Camera: Remidio FOP fundus camera, fundus photo, image size 1659x2212:
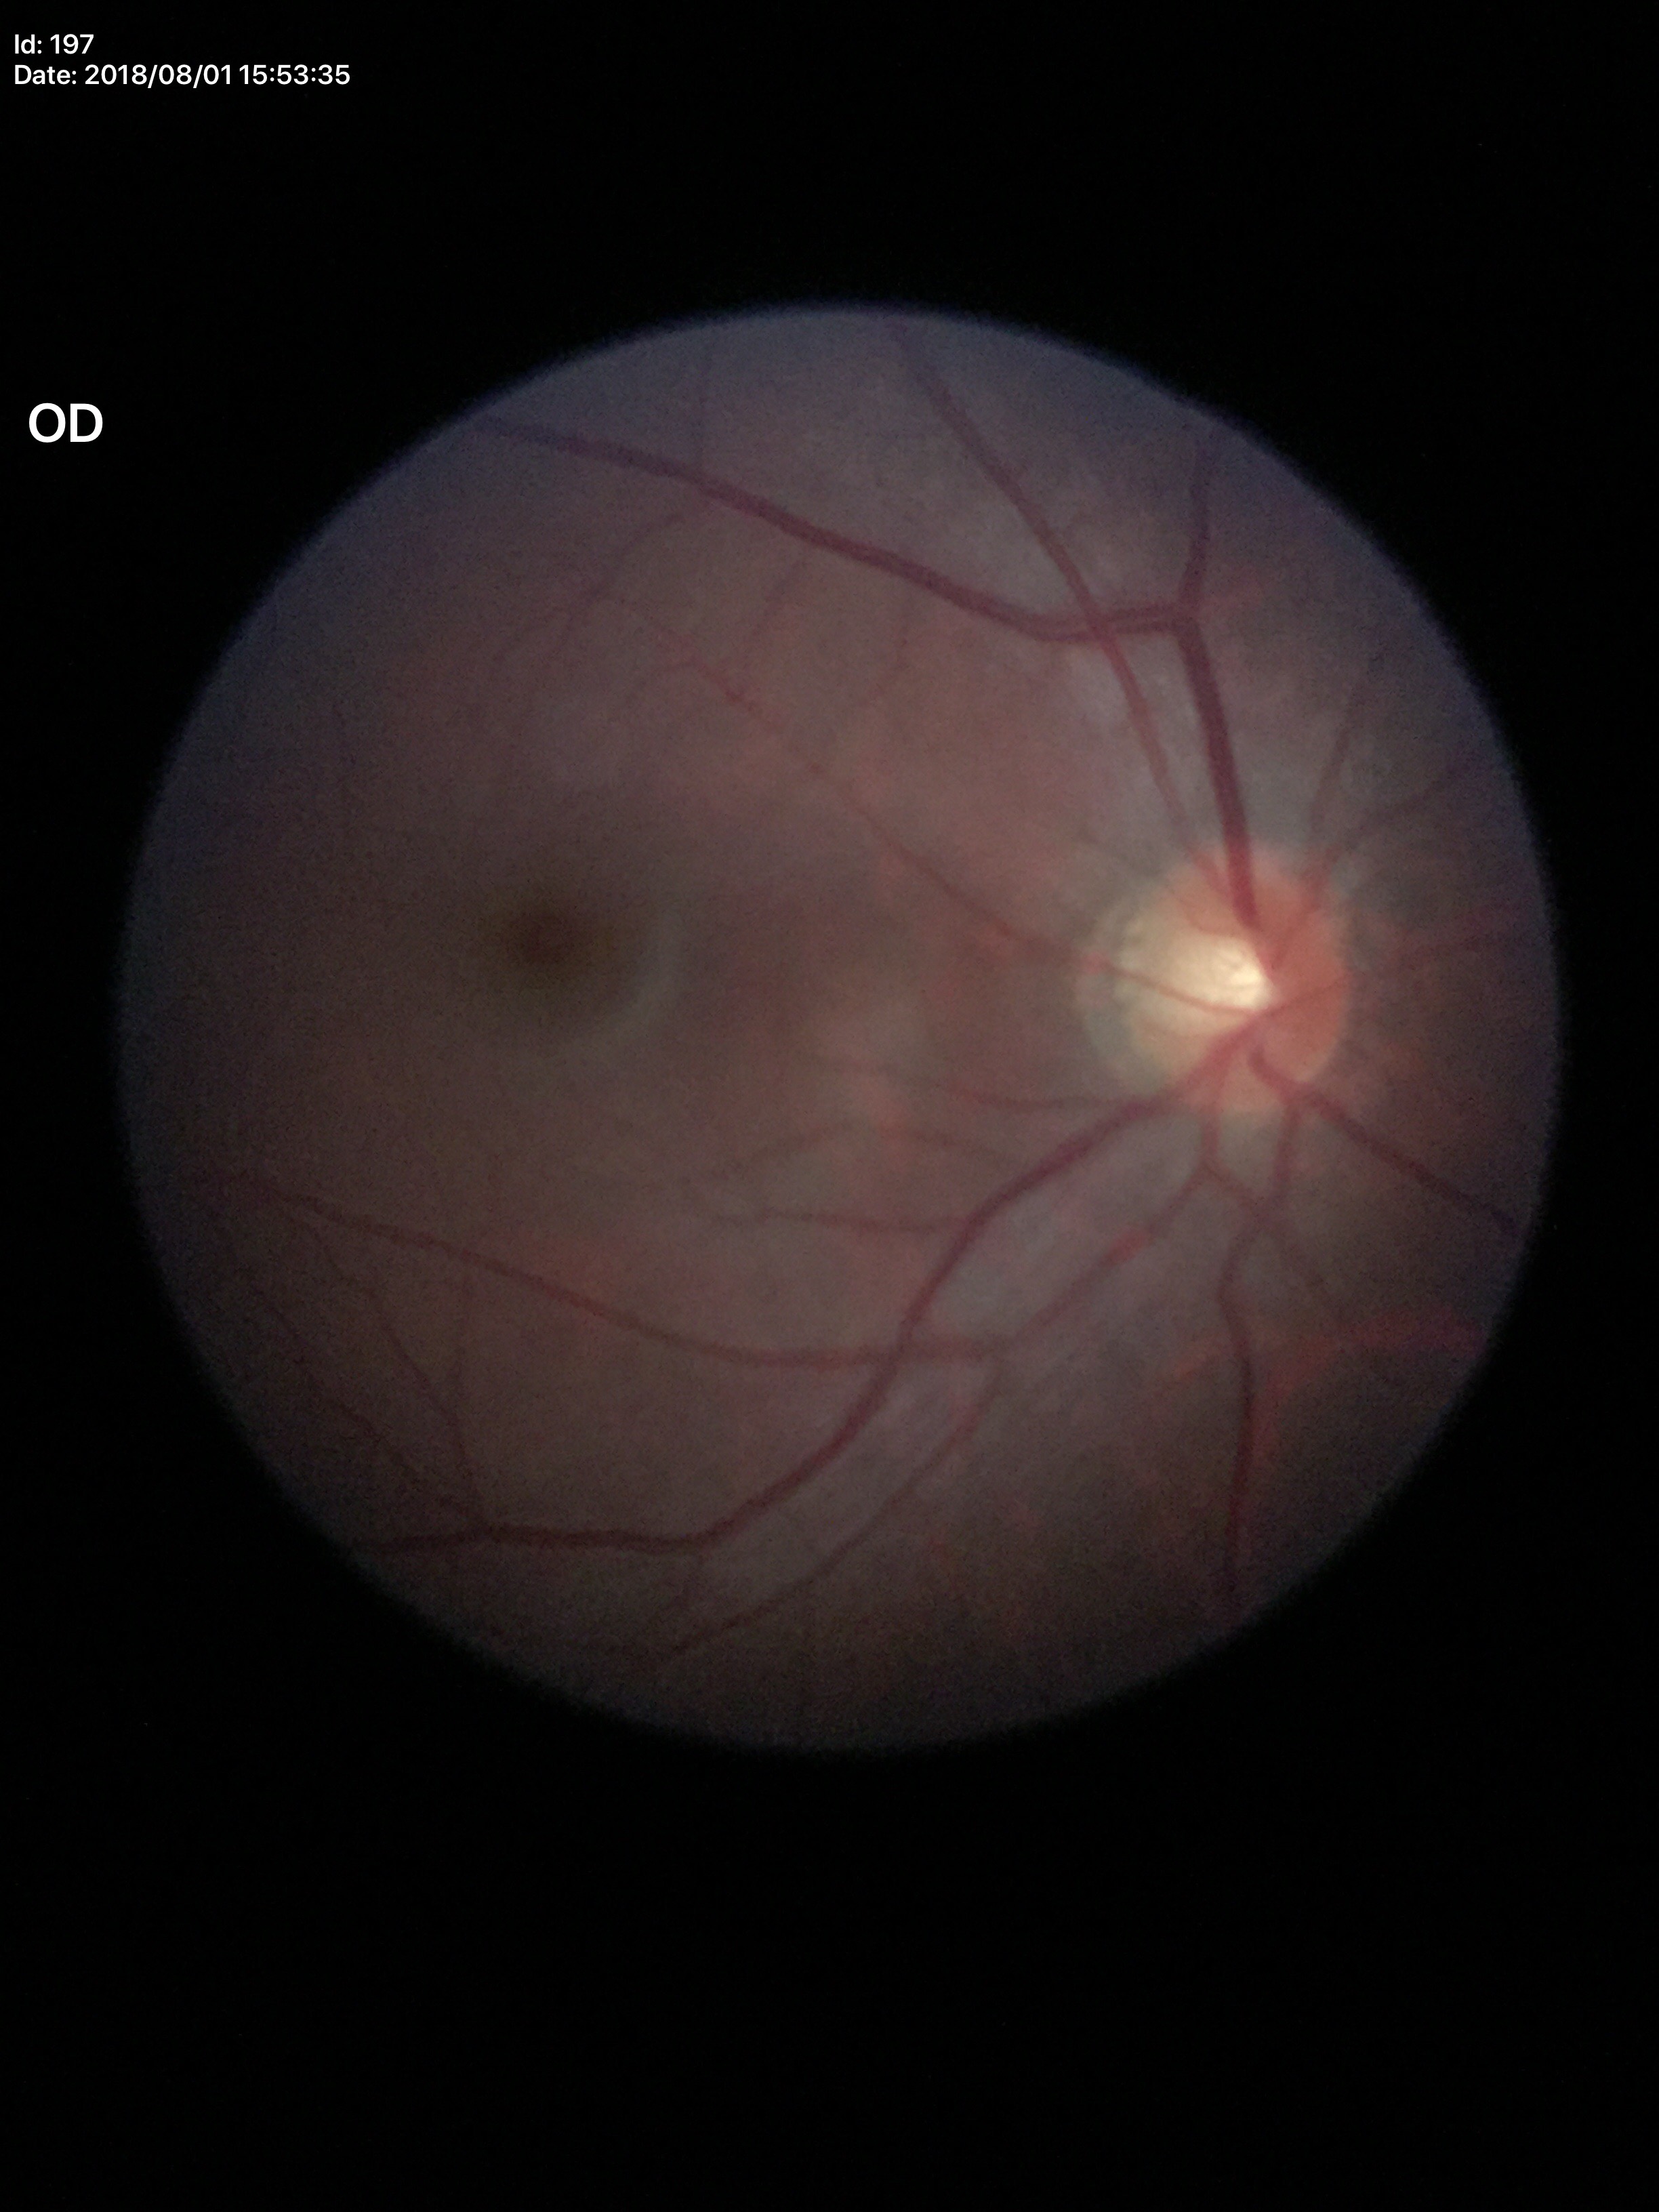 No glaucomatous optic neuropathy.
VCDR: 0.48.